45-degree field of view — 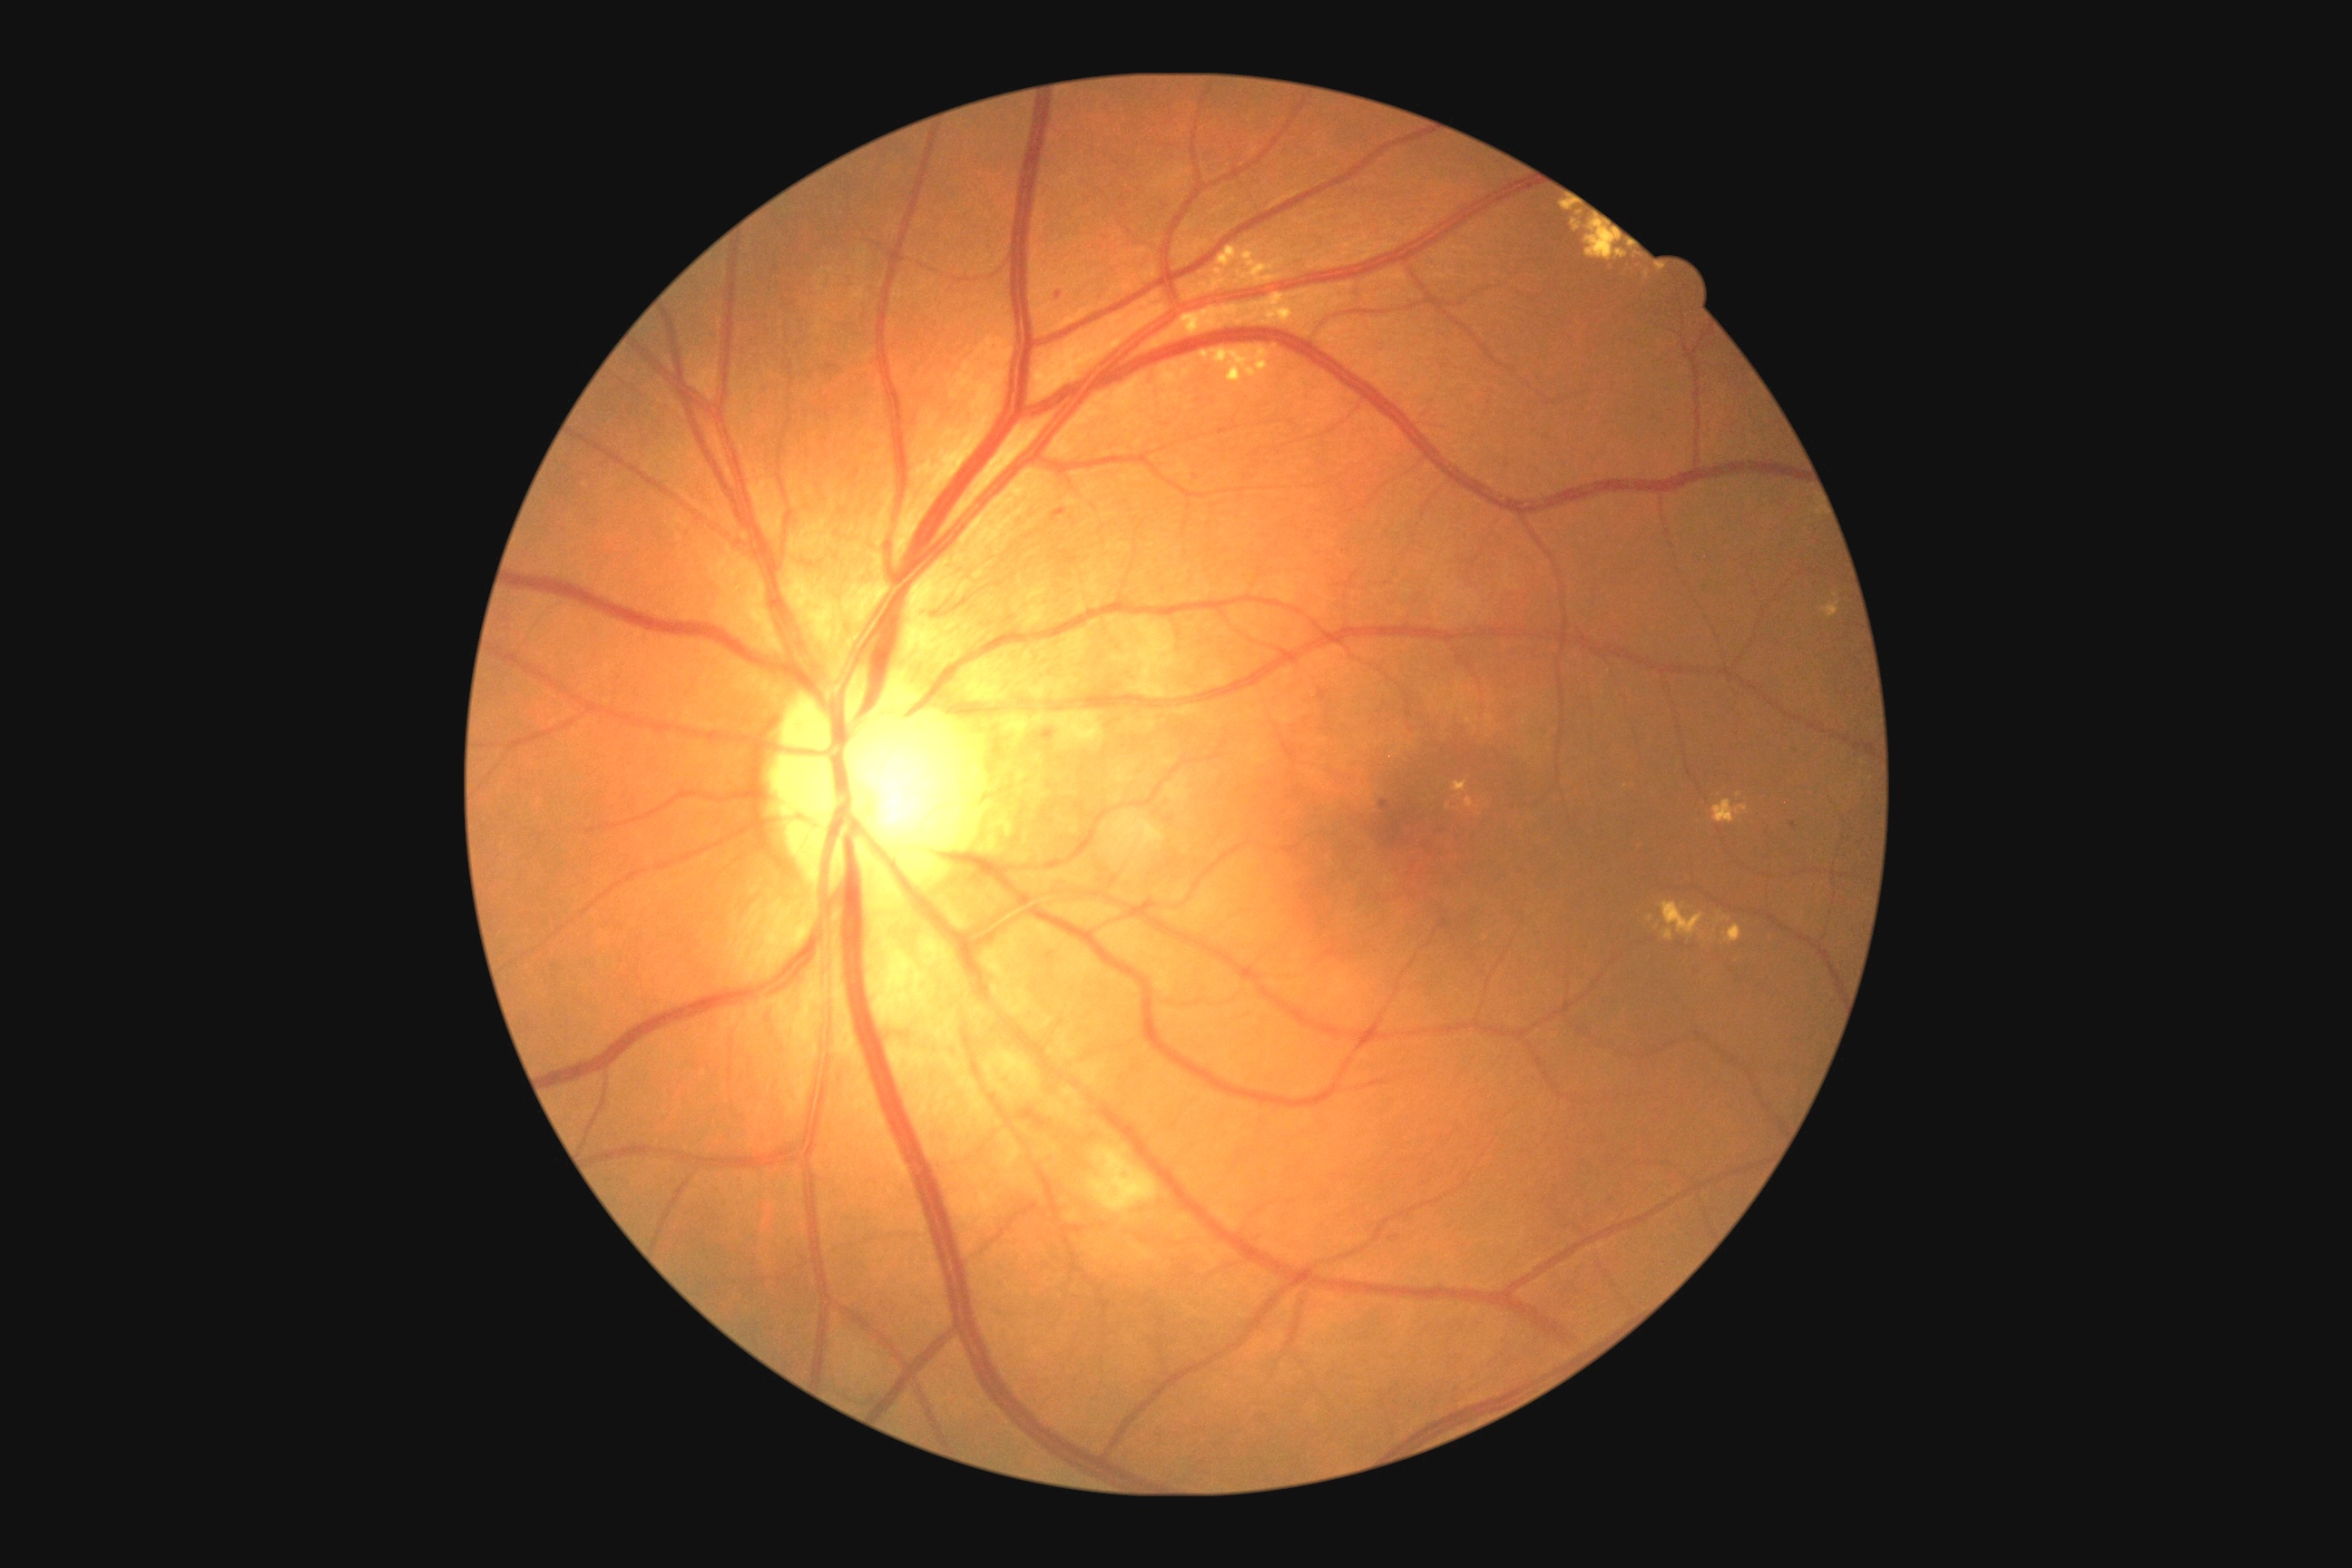
Diabetic retinopathy grade is 2 (moderate NPDR).
The retinopathy is classified as non-proliferative diabetic retinopathy.